Nidek AFC-330.
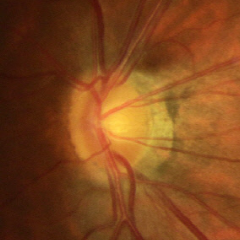
Glaucoma assessment: early glaucomatous optic neuropathy.